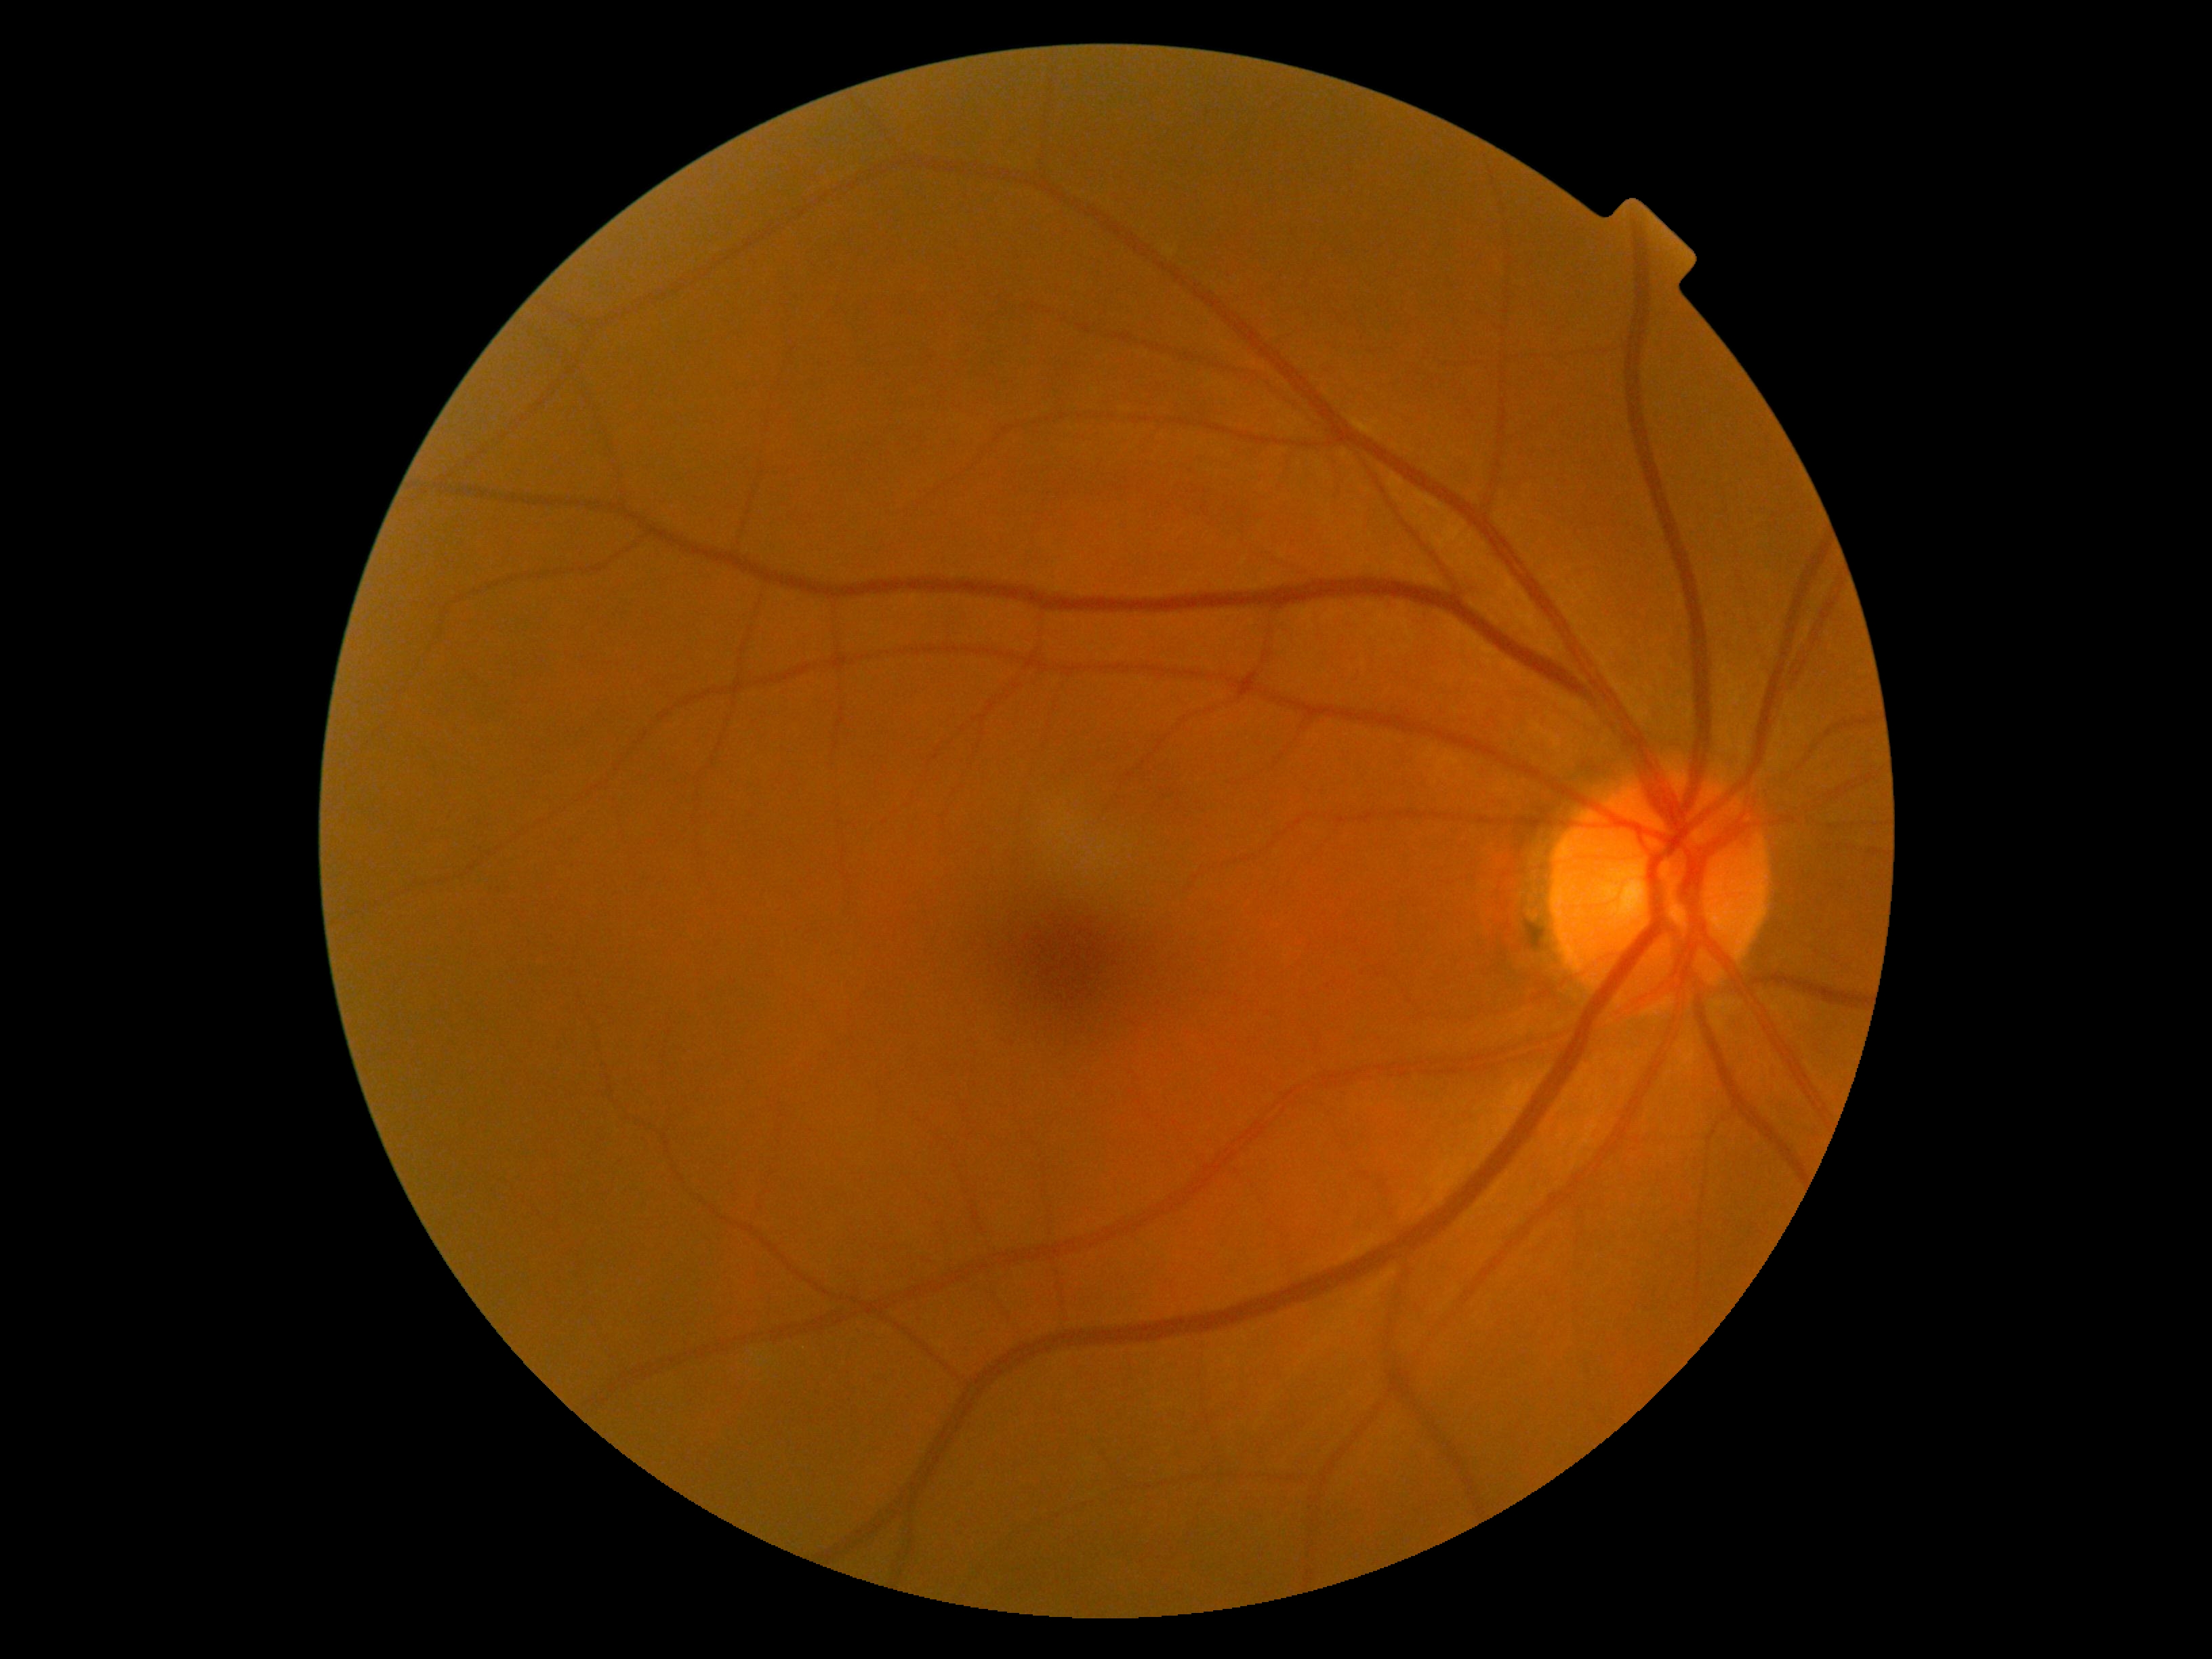
Retinopathy is no apparent diabetic retinopathy (grade 0).